Diabetic retinopathy graded by the modified Davis classification, 848 by 848 pixels, without pupil dilation
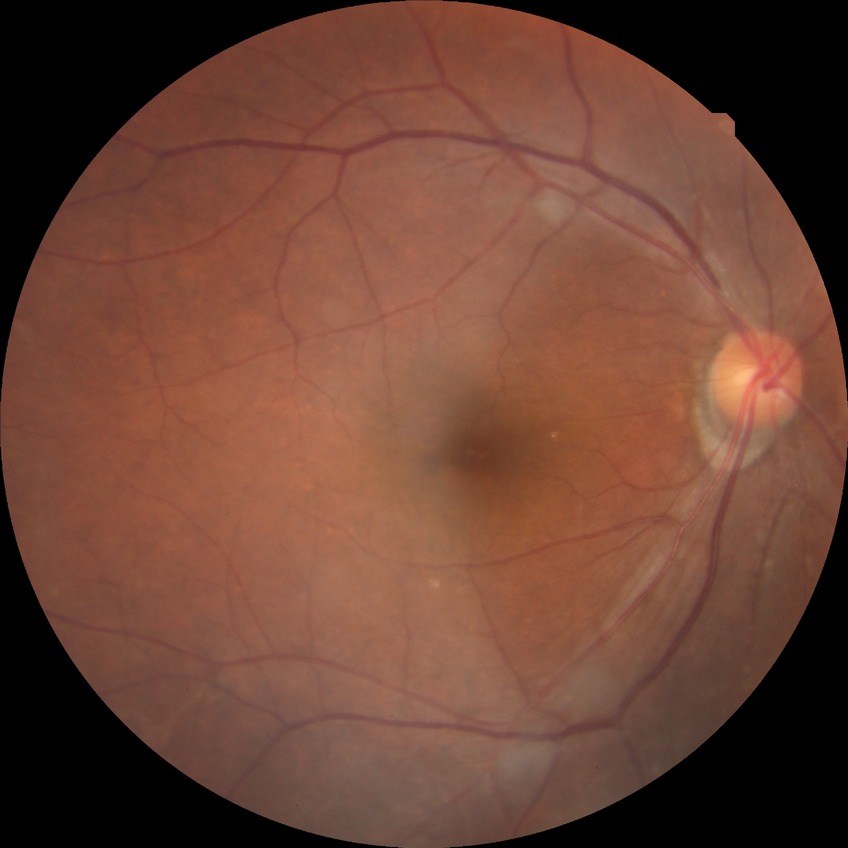
Modified Davis grade is NDR. No signs of diabetic retinopathy.